CFP; nonmydriatic fundus photograph; Davis DR grading; 848 x 848 pixels.
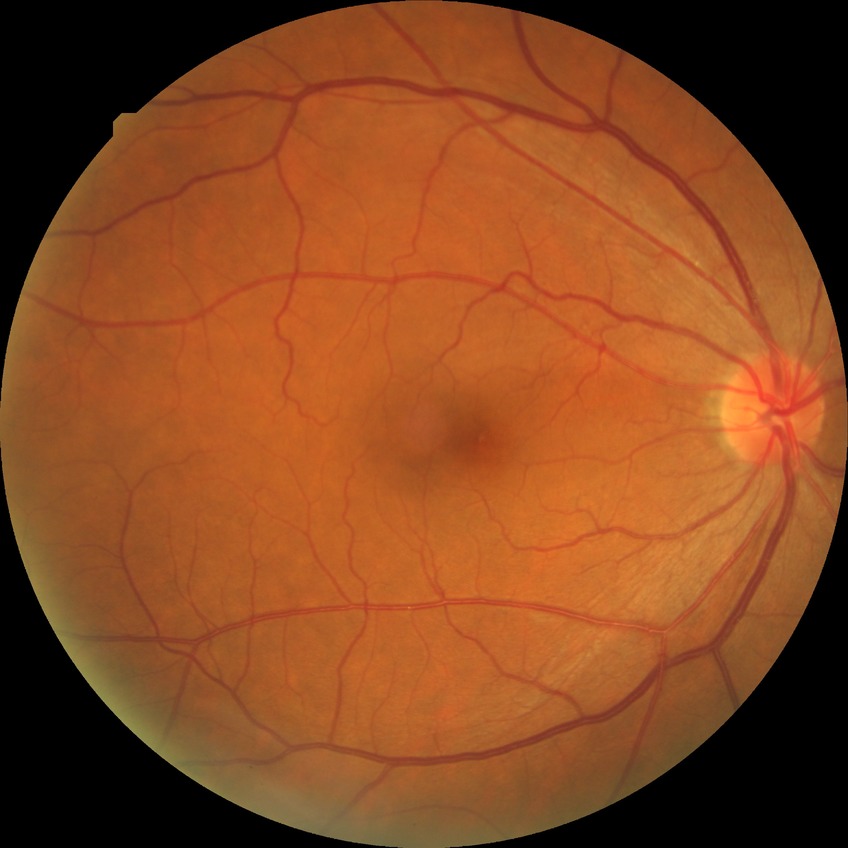

  davis_grade: NDR (no diabetic retinopathy)